Color fundus photograph. 2352x1568px — 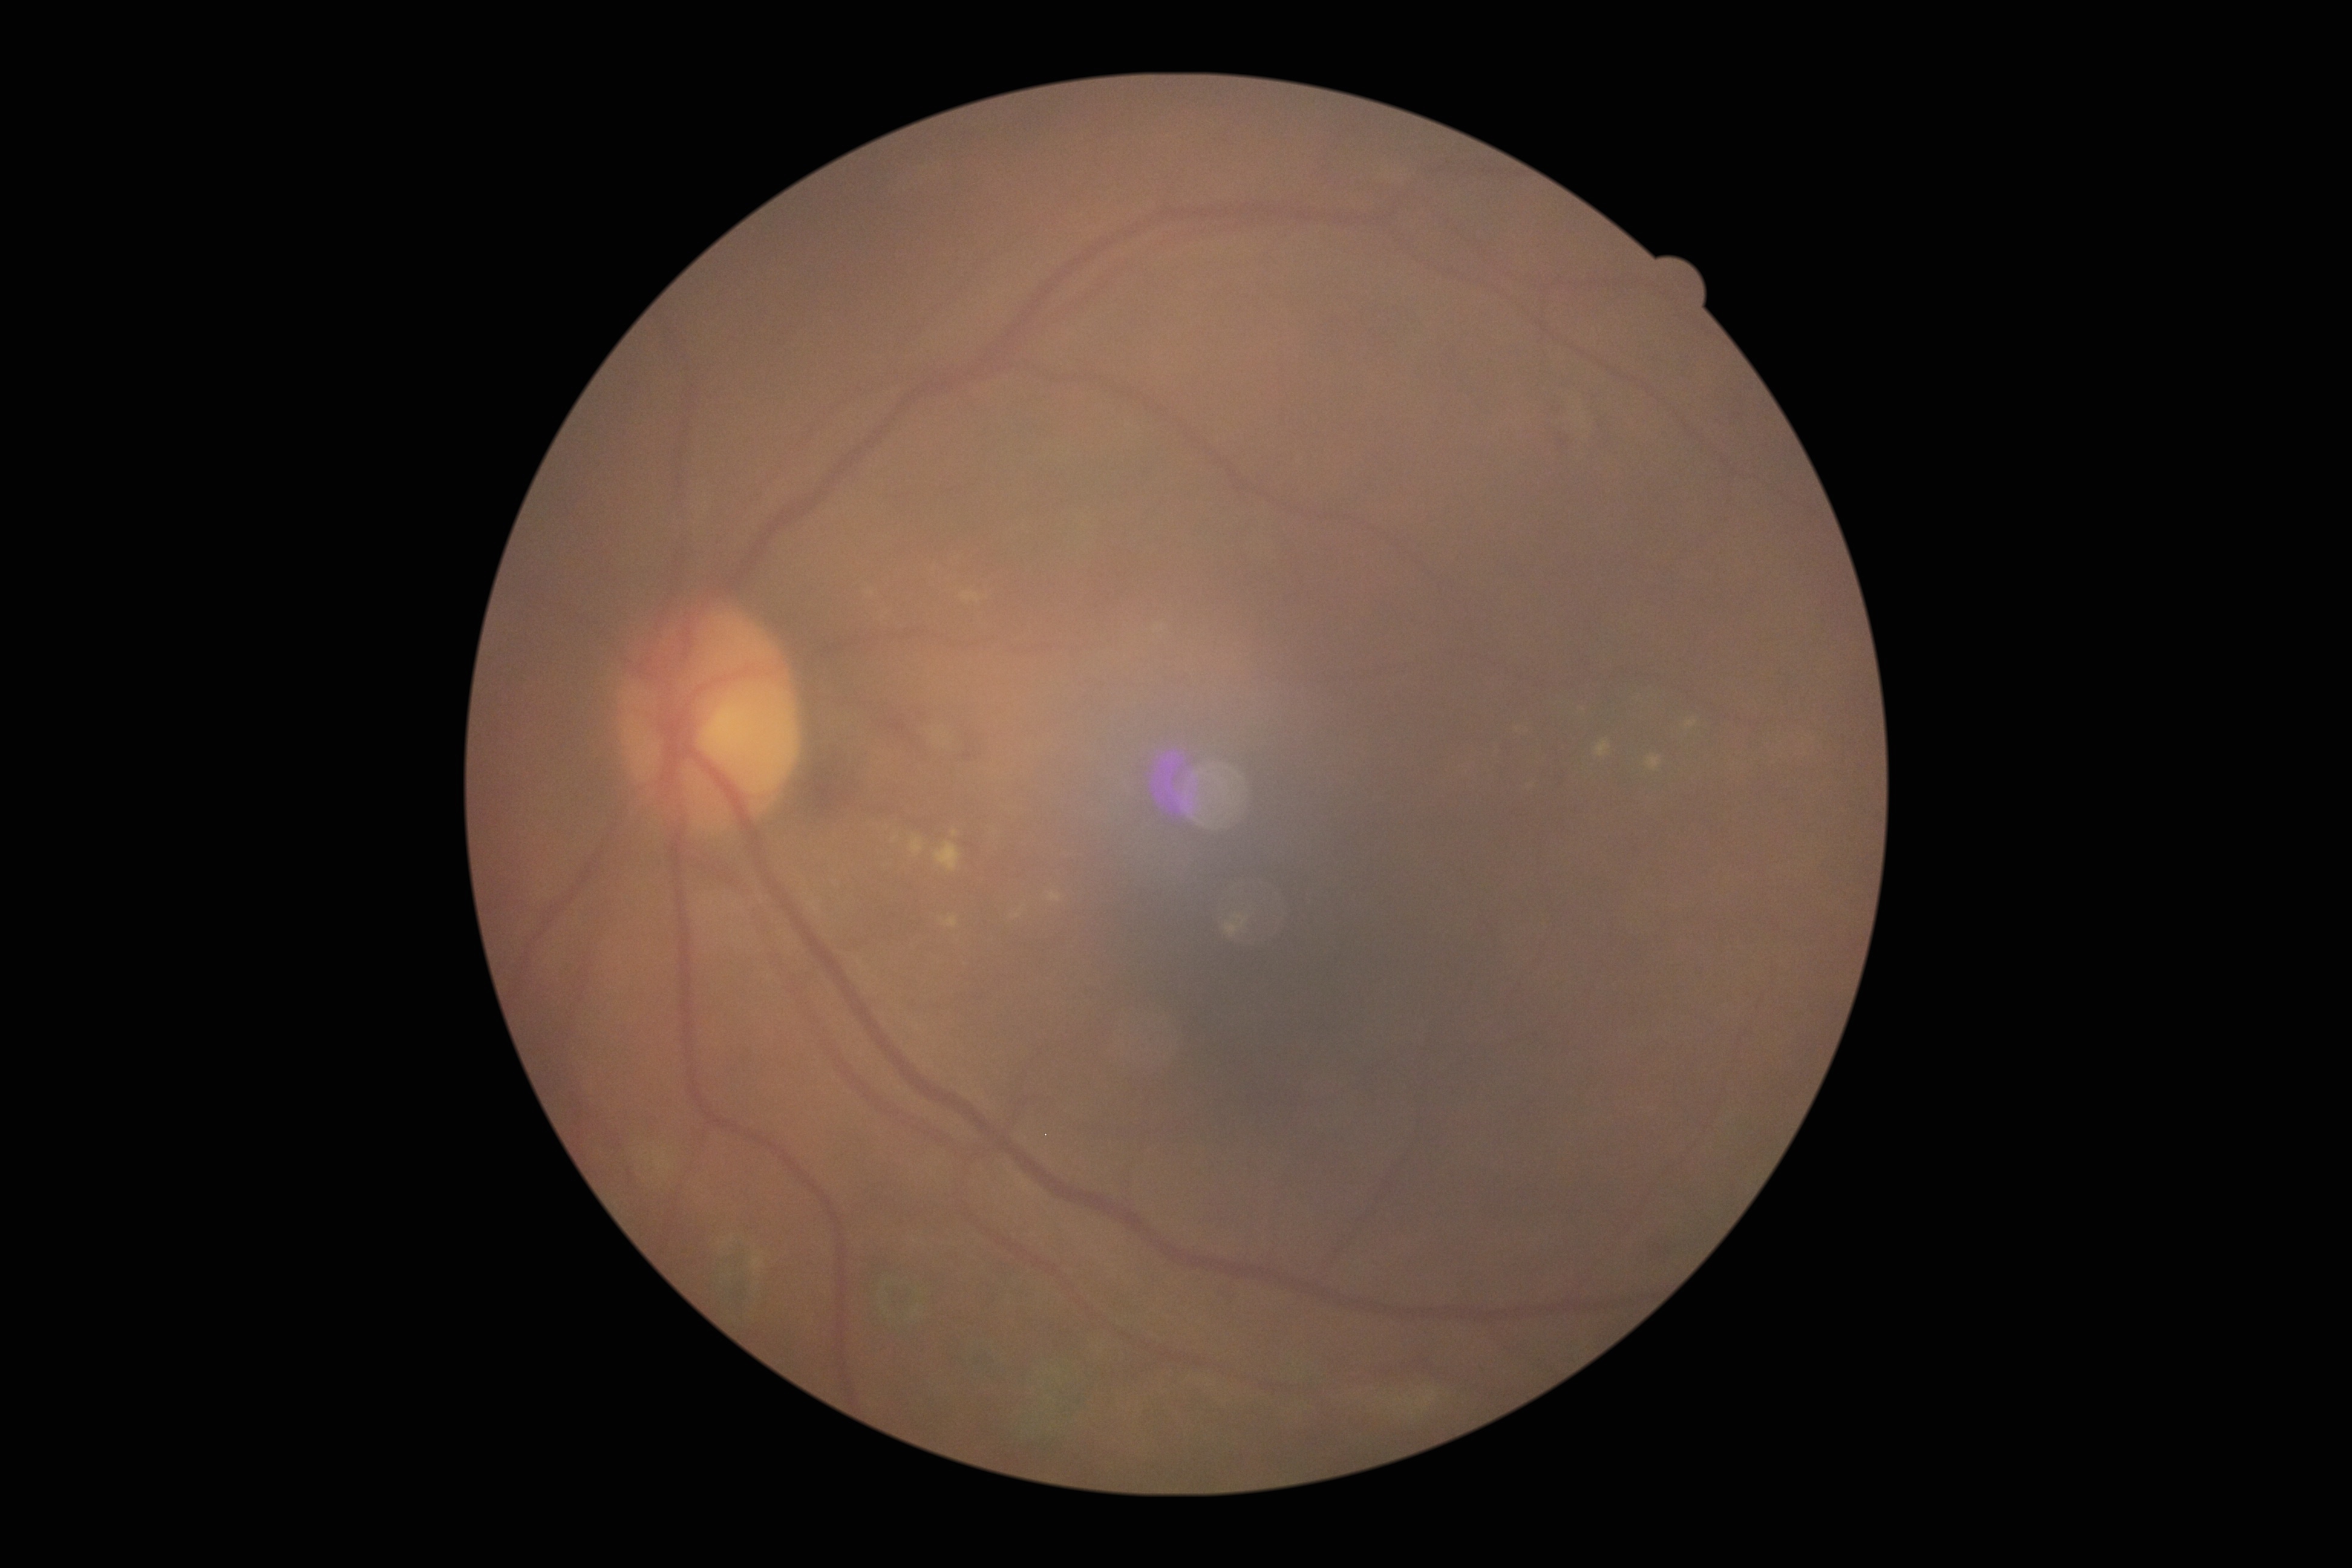 DR stage: moderate non-proliferative diabetic retinopathy (grade 2).